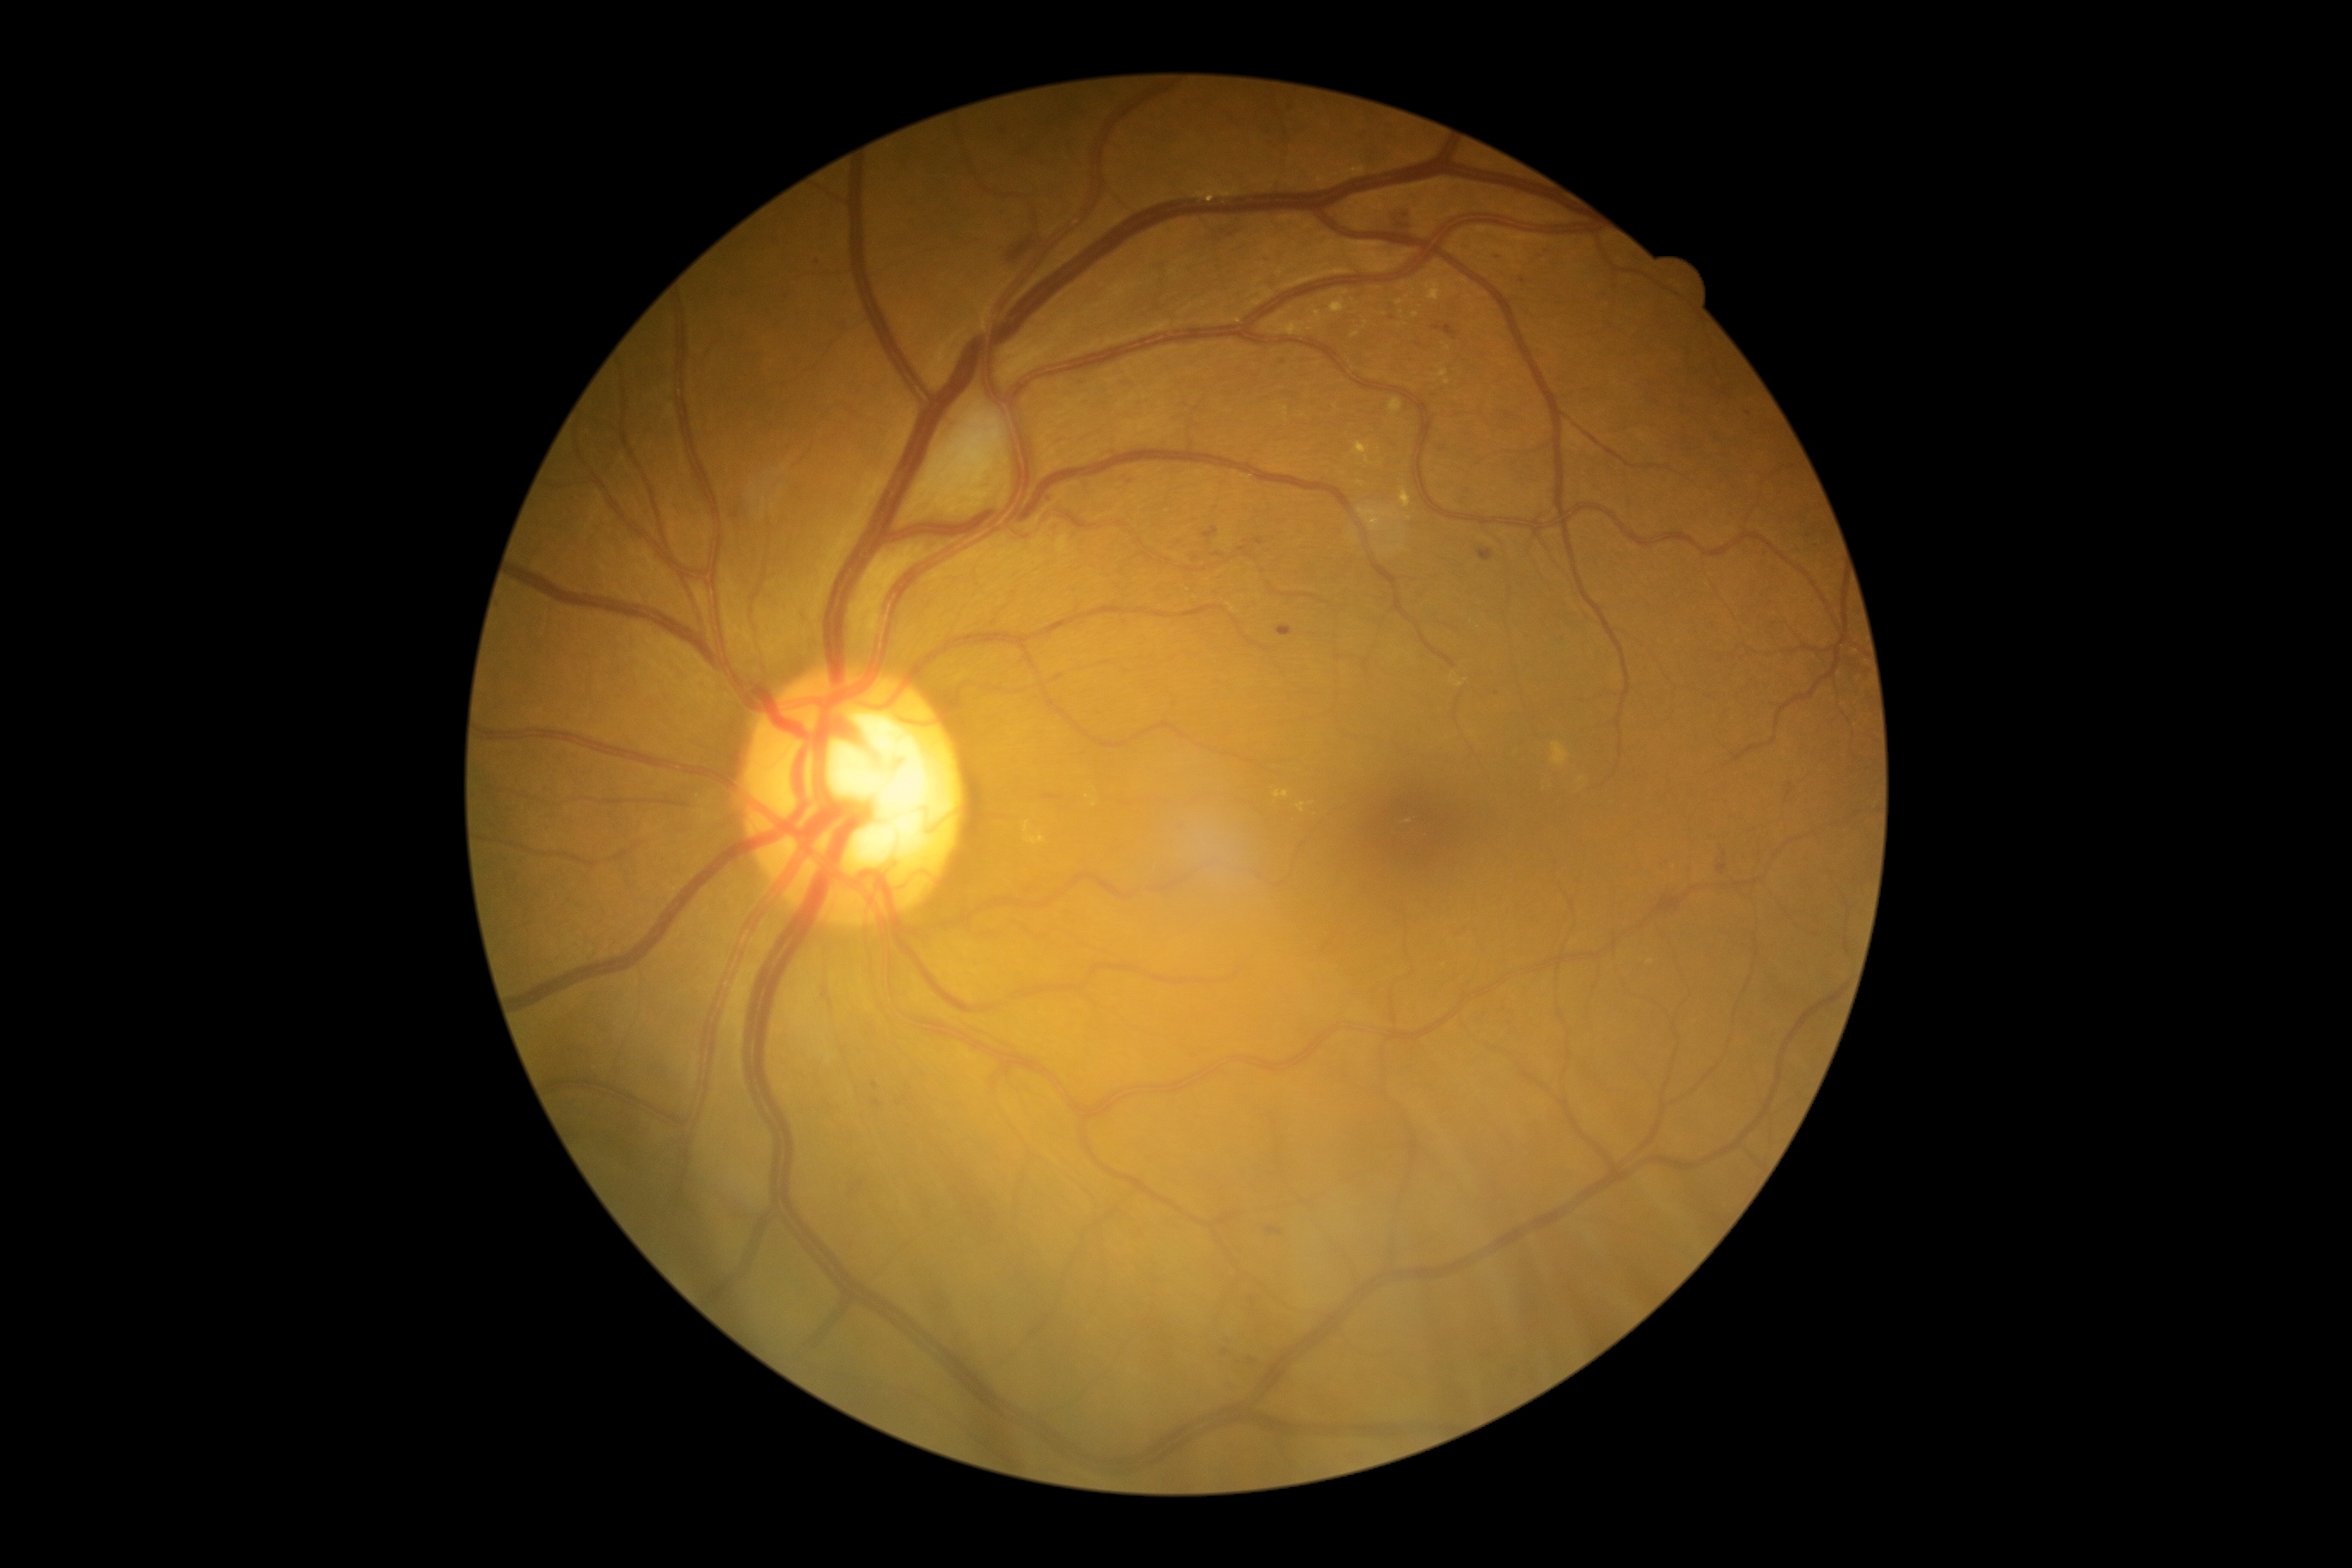 dr_grade: moderate NPDR (2)